FOV: 60 degrees:
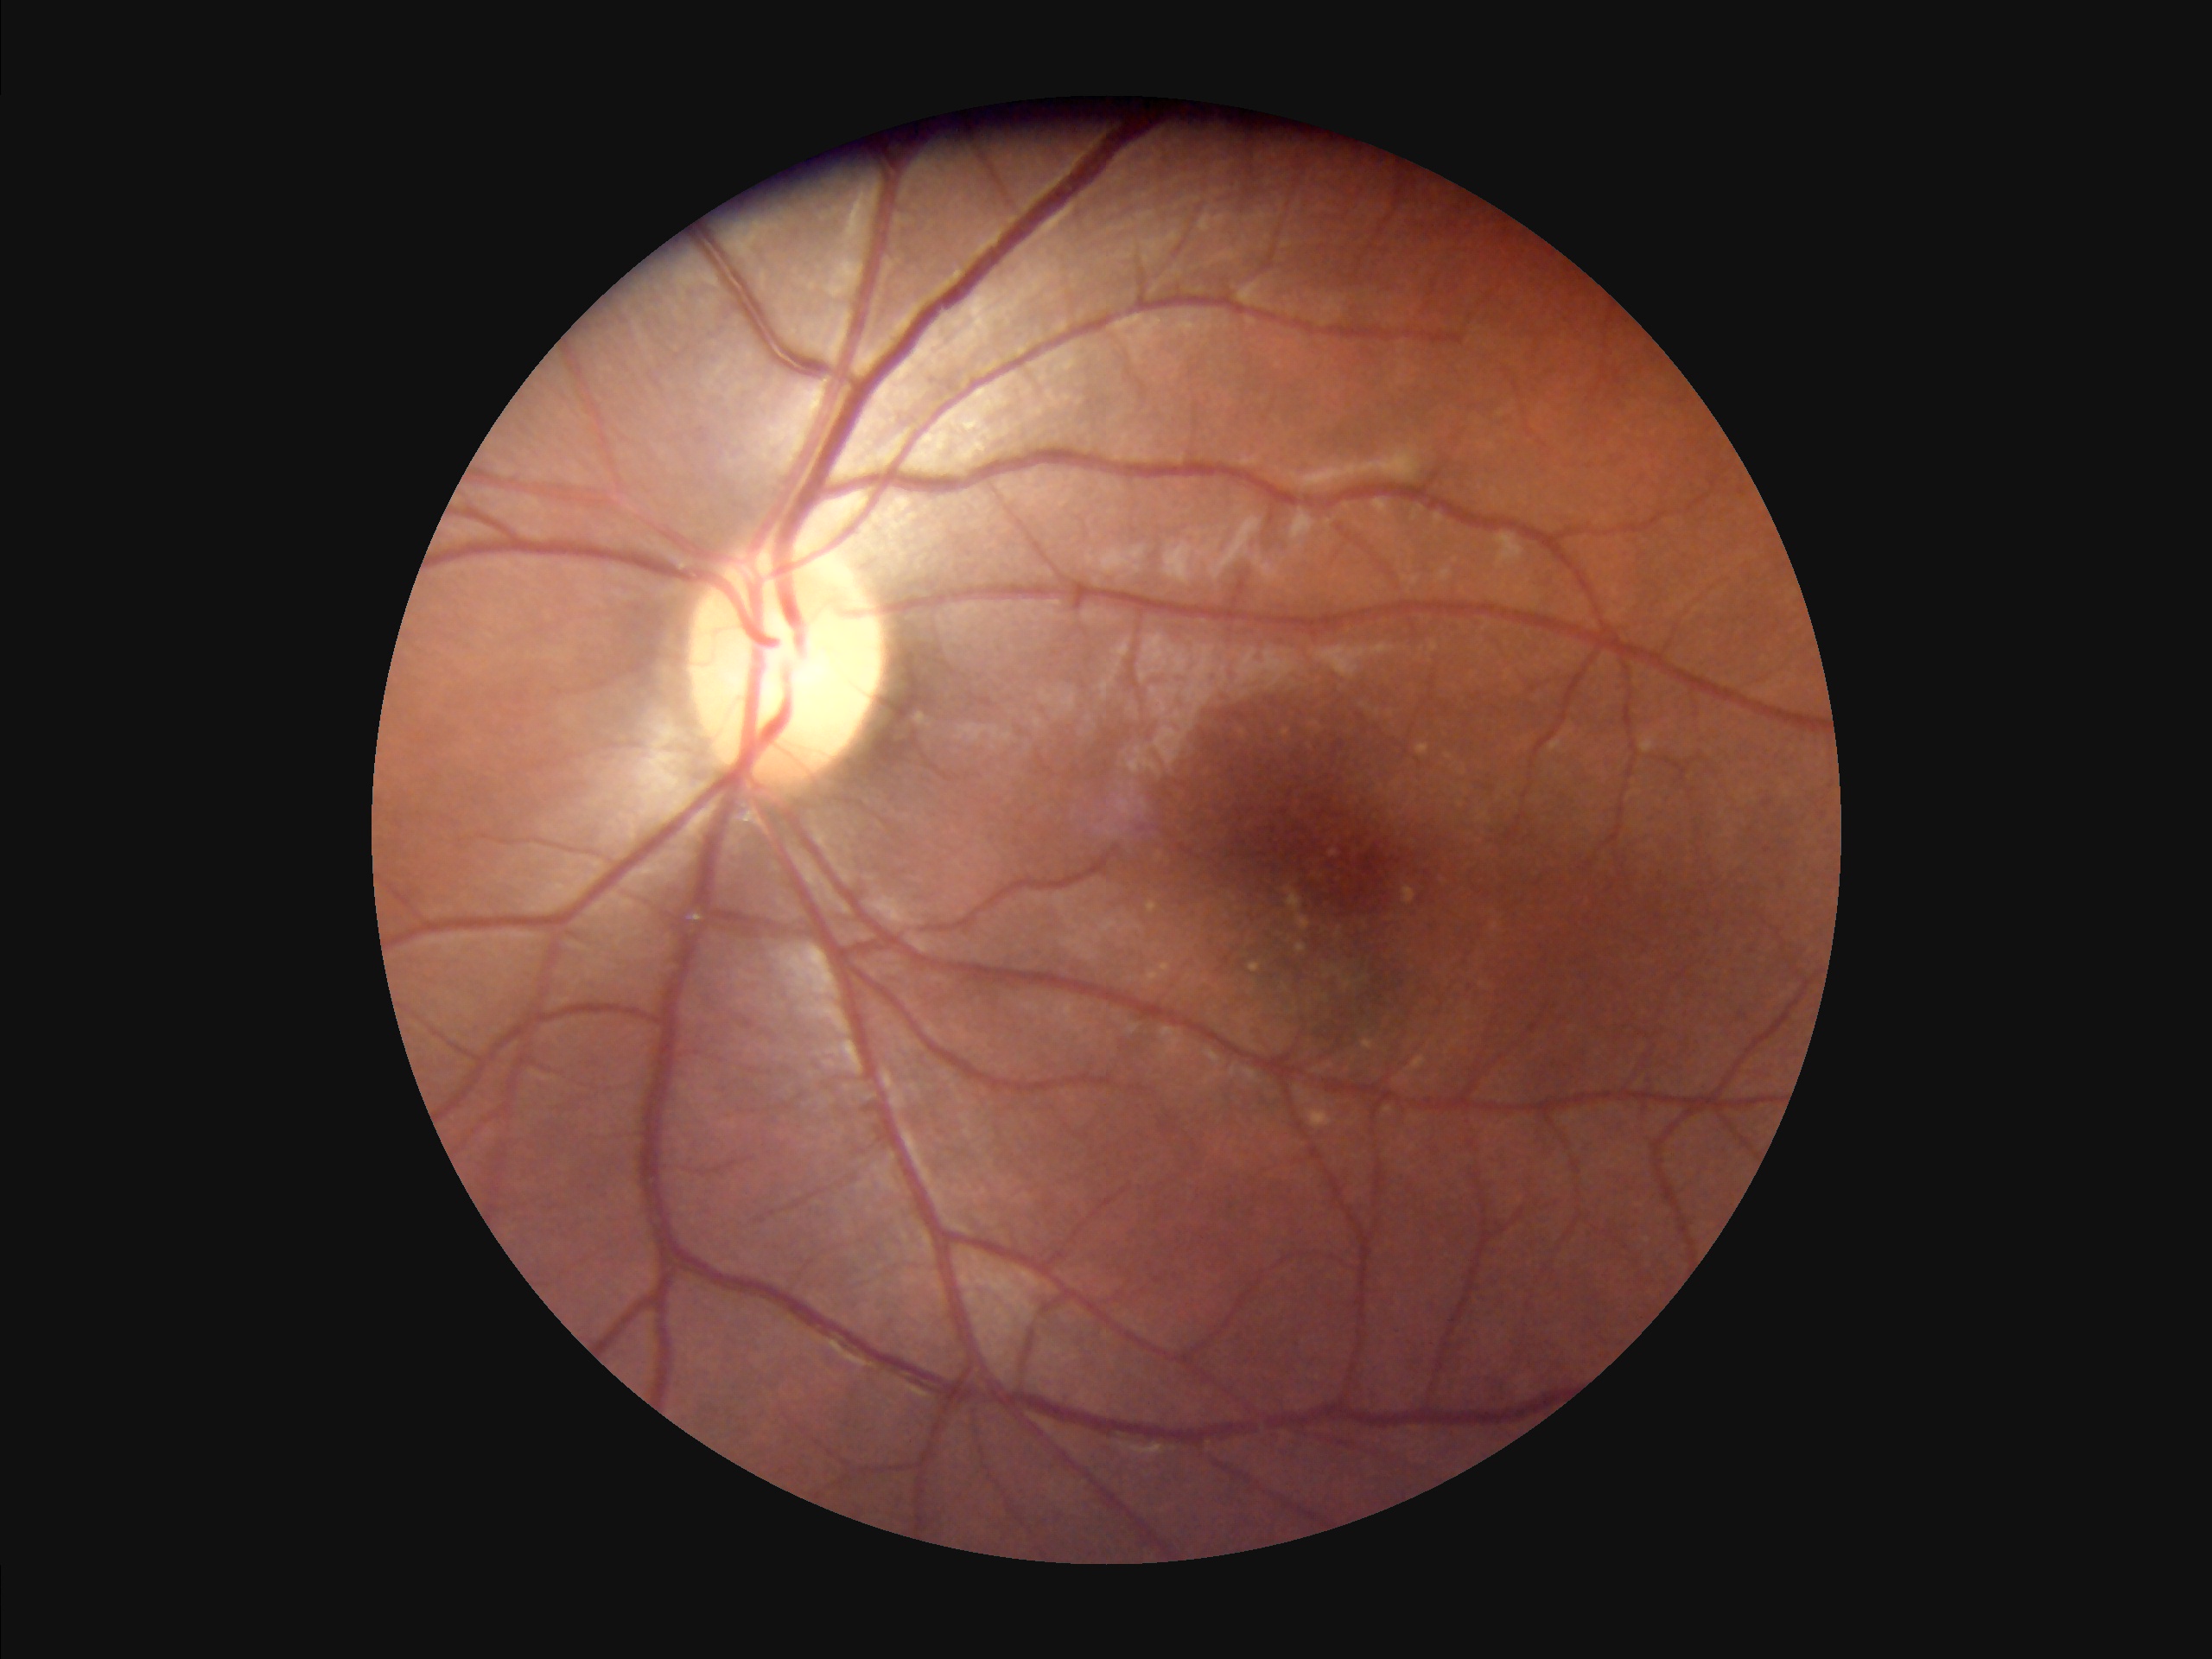 Quality grading: contrast: vessels and details readily distinguishable | overall: adequate for clinical interpretation | illumination/color: no over- or under-exposure.